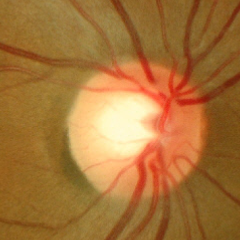
Glaucoma is present. Glaucoma diagnosis: early-stage glaucoma.